Wide-field contact fundus photograph of an infant · Natus RetCam Envision, 130° FOV.
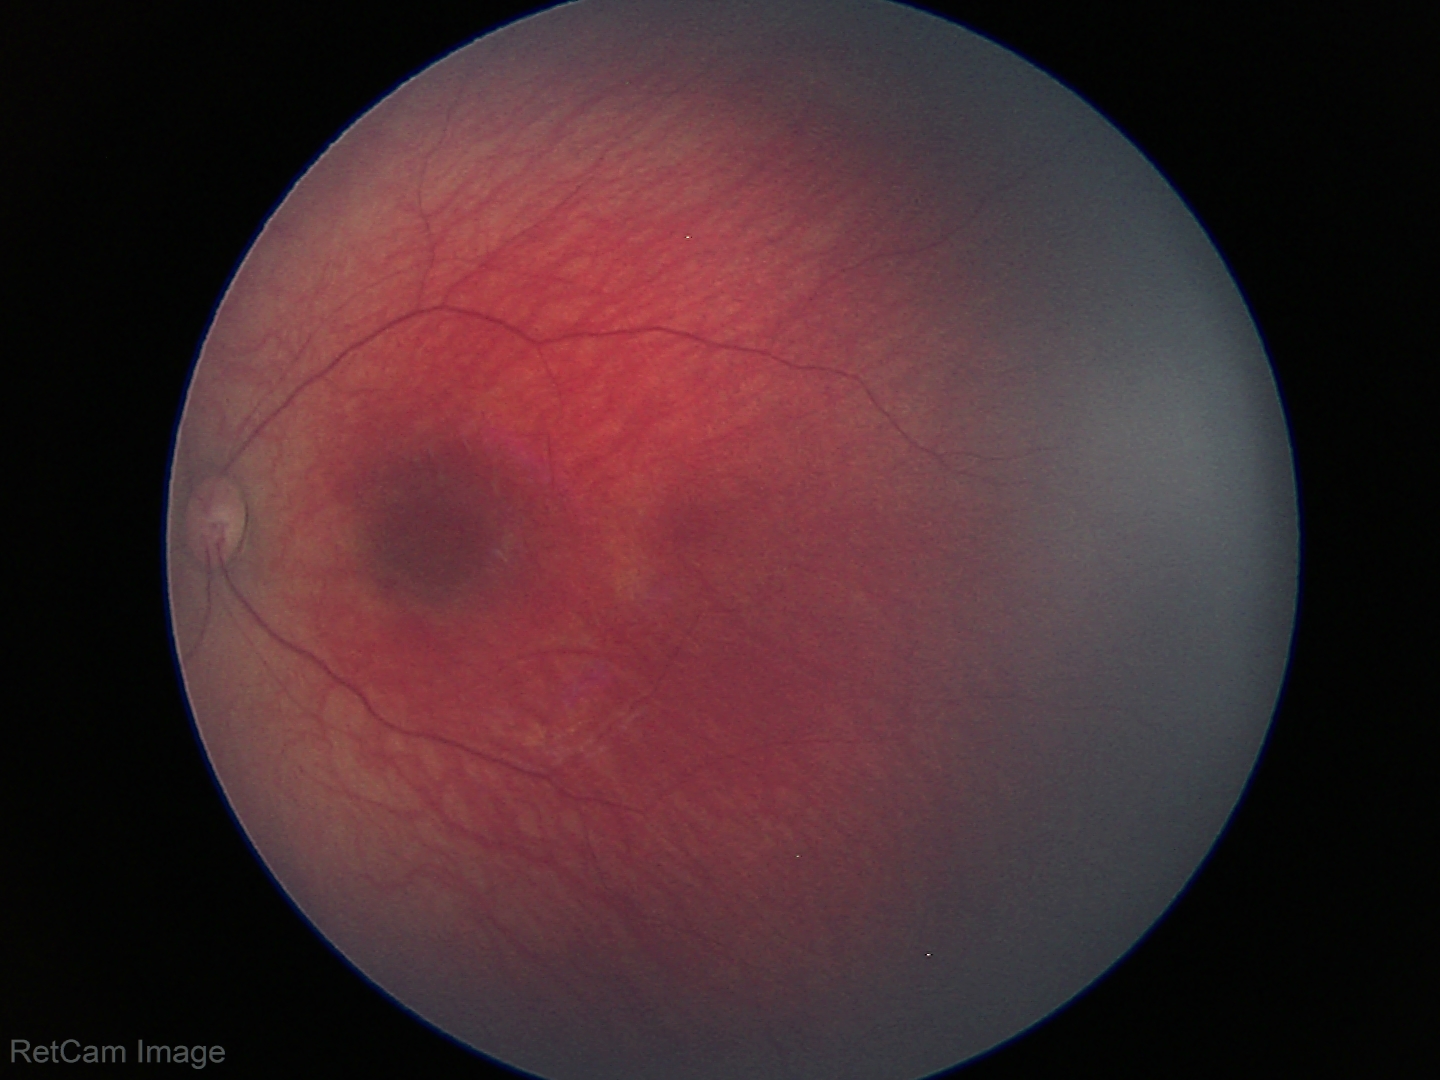

Diagnosis = physiological appearance.